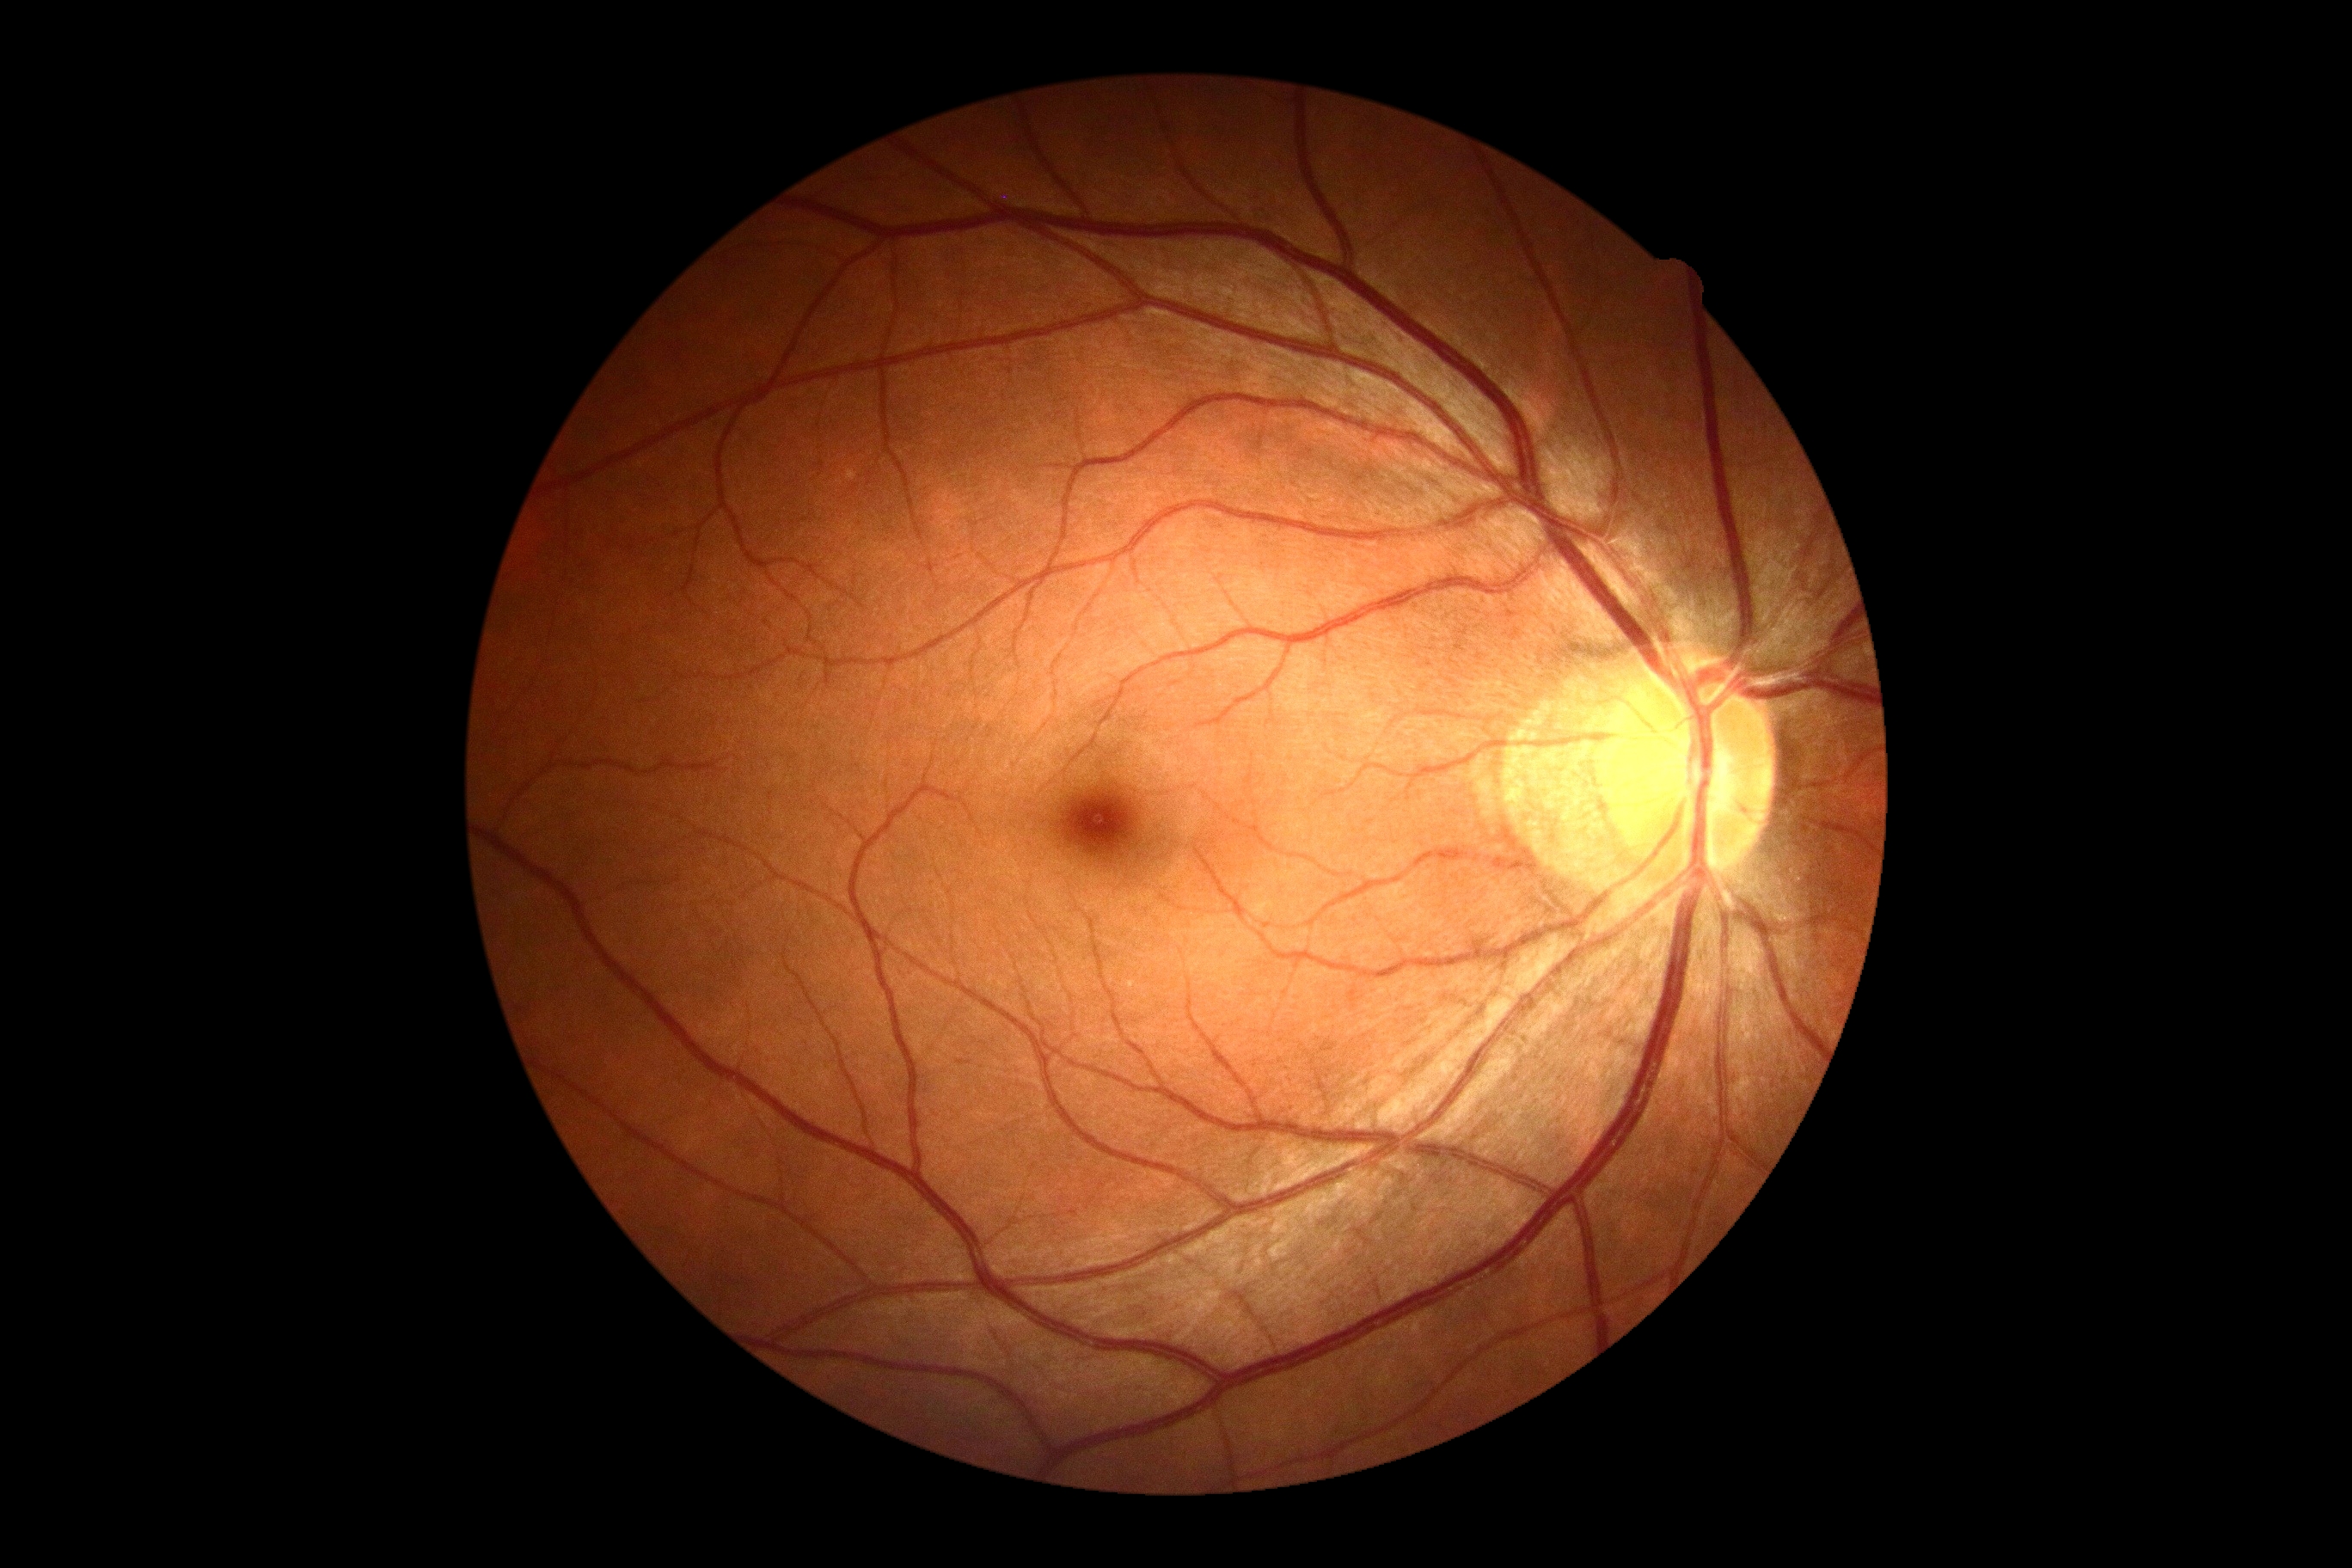
DR severity: grade 0 (no apparent retinopathy).